45° field of view:
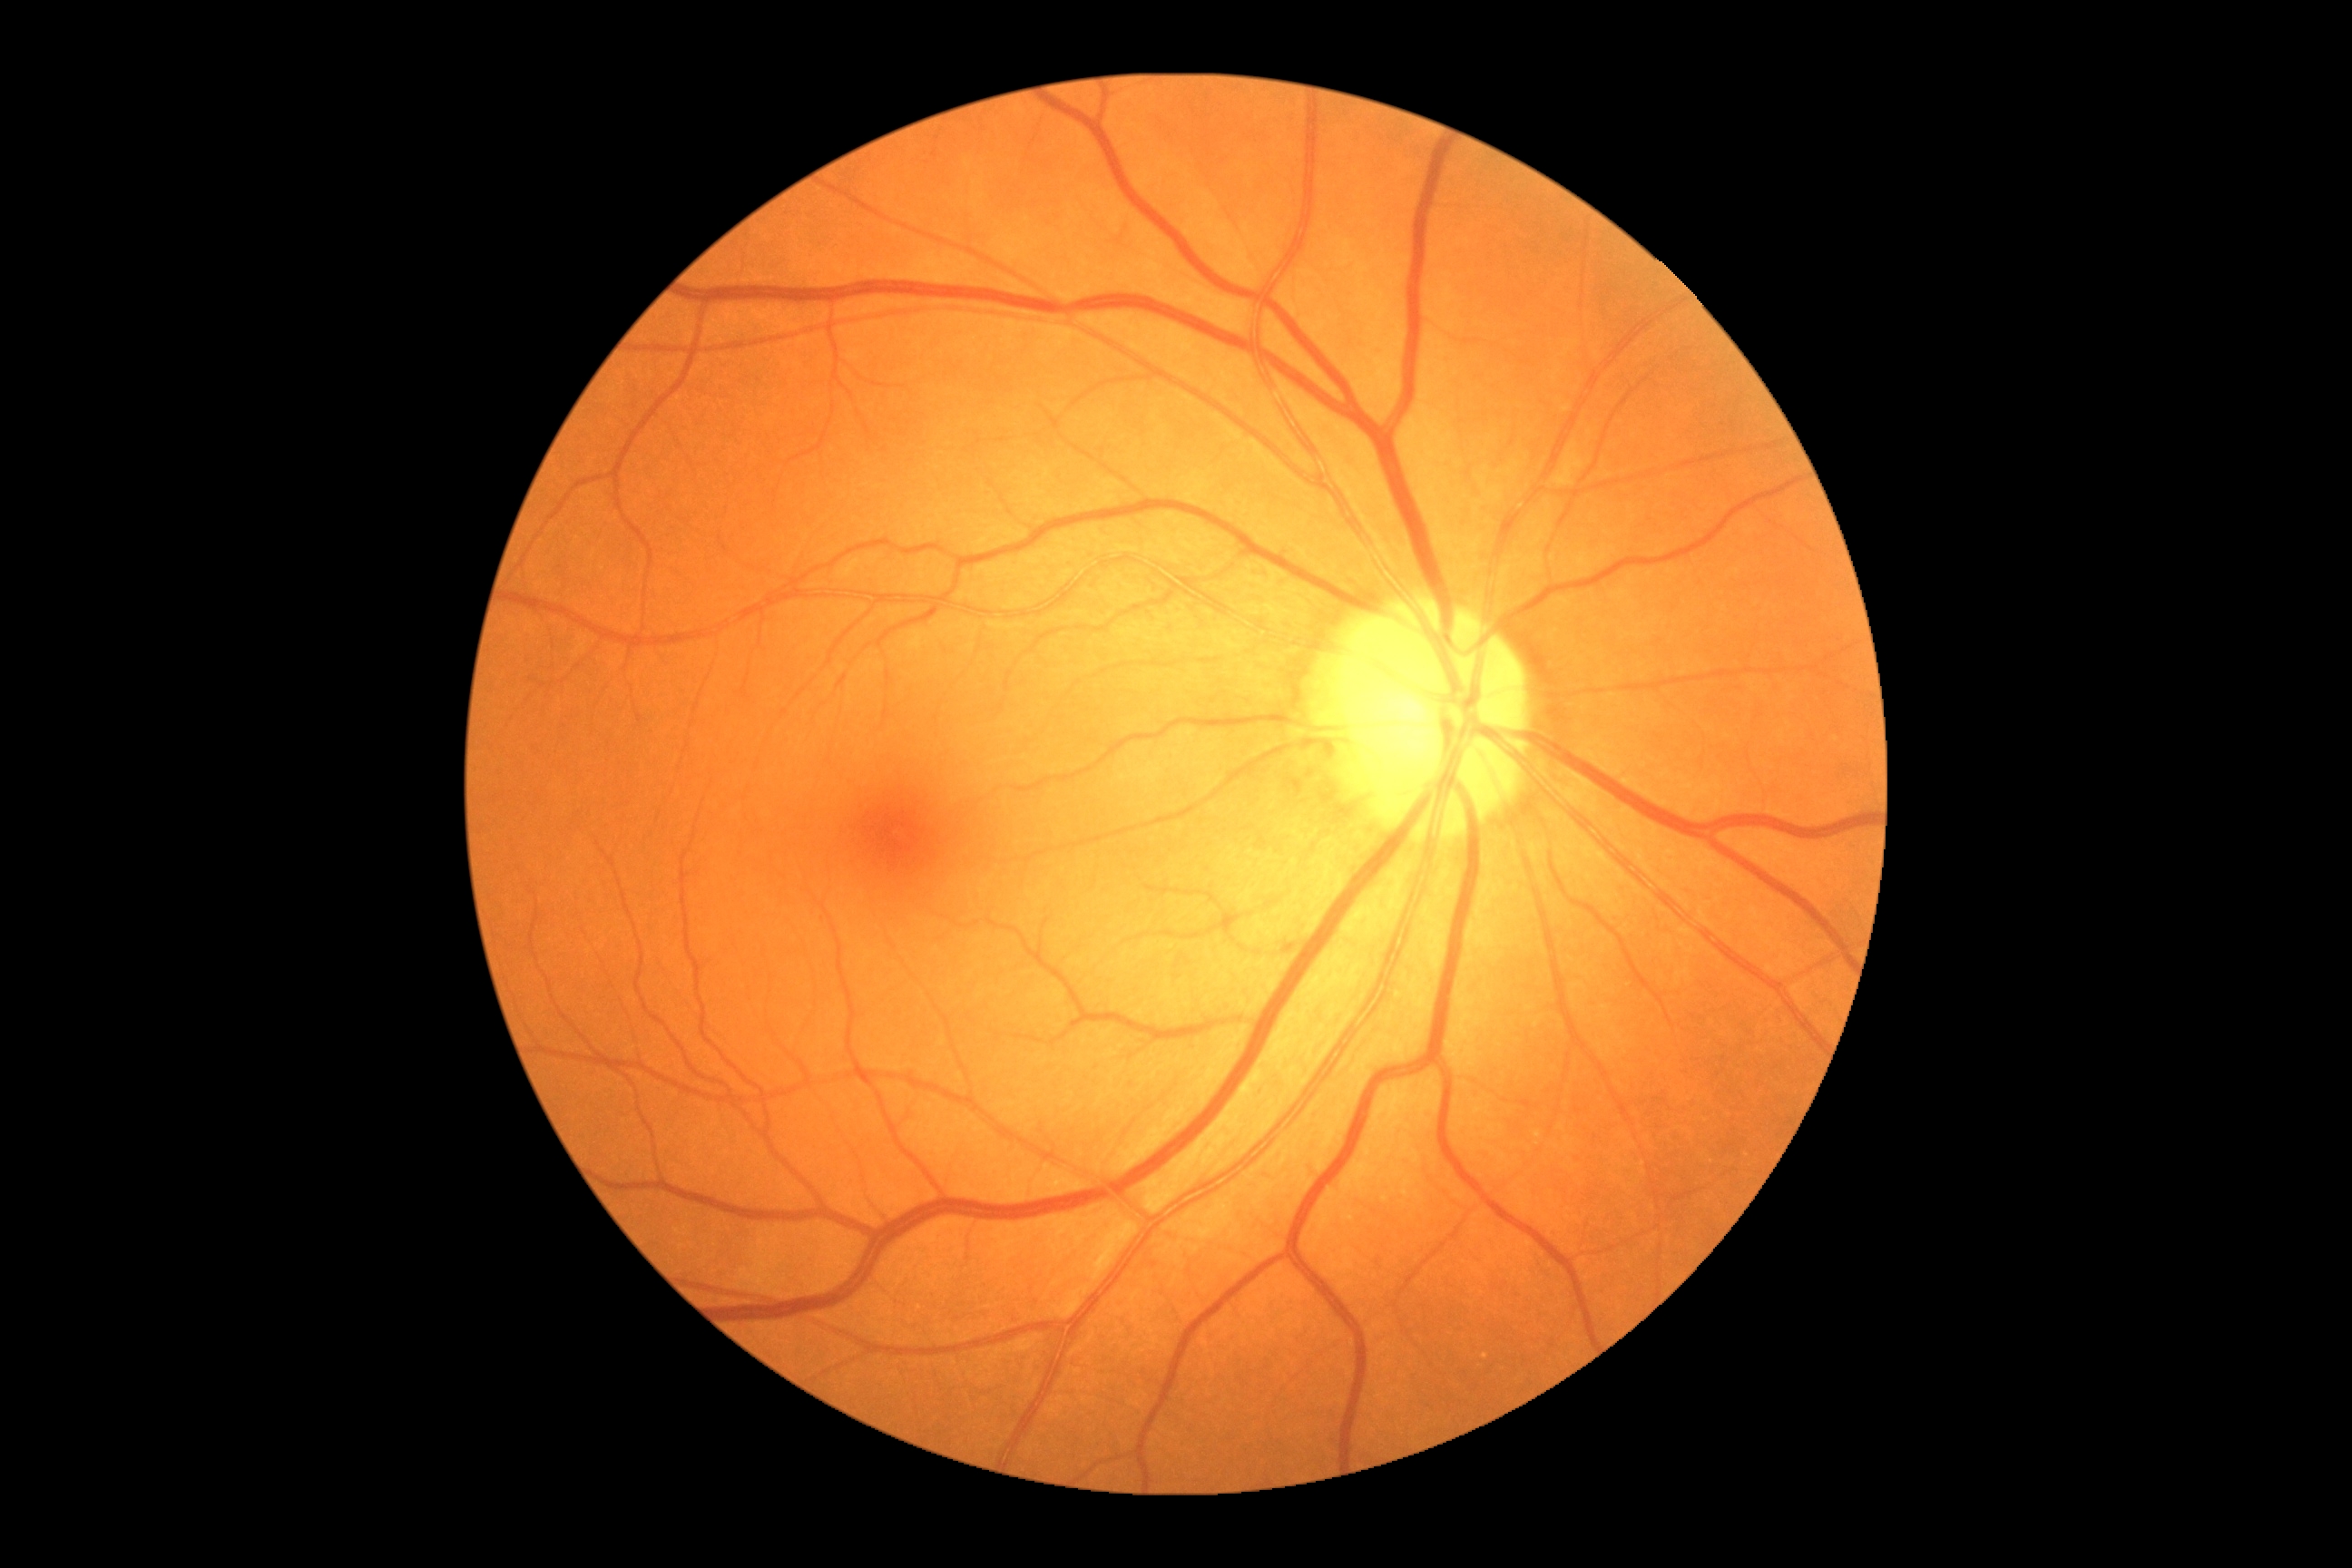

Diabetic retinopathy (DR): no apparent retinopathy (grade 0) — no visible signs of diabetic retinopathy.
No signs of diabetic retinopathy.